Camera: Phoenix ICON (100° FOV). Image size 1240x1240. Wide-field fundus photograph of an infant:
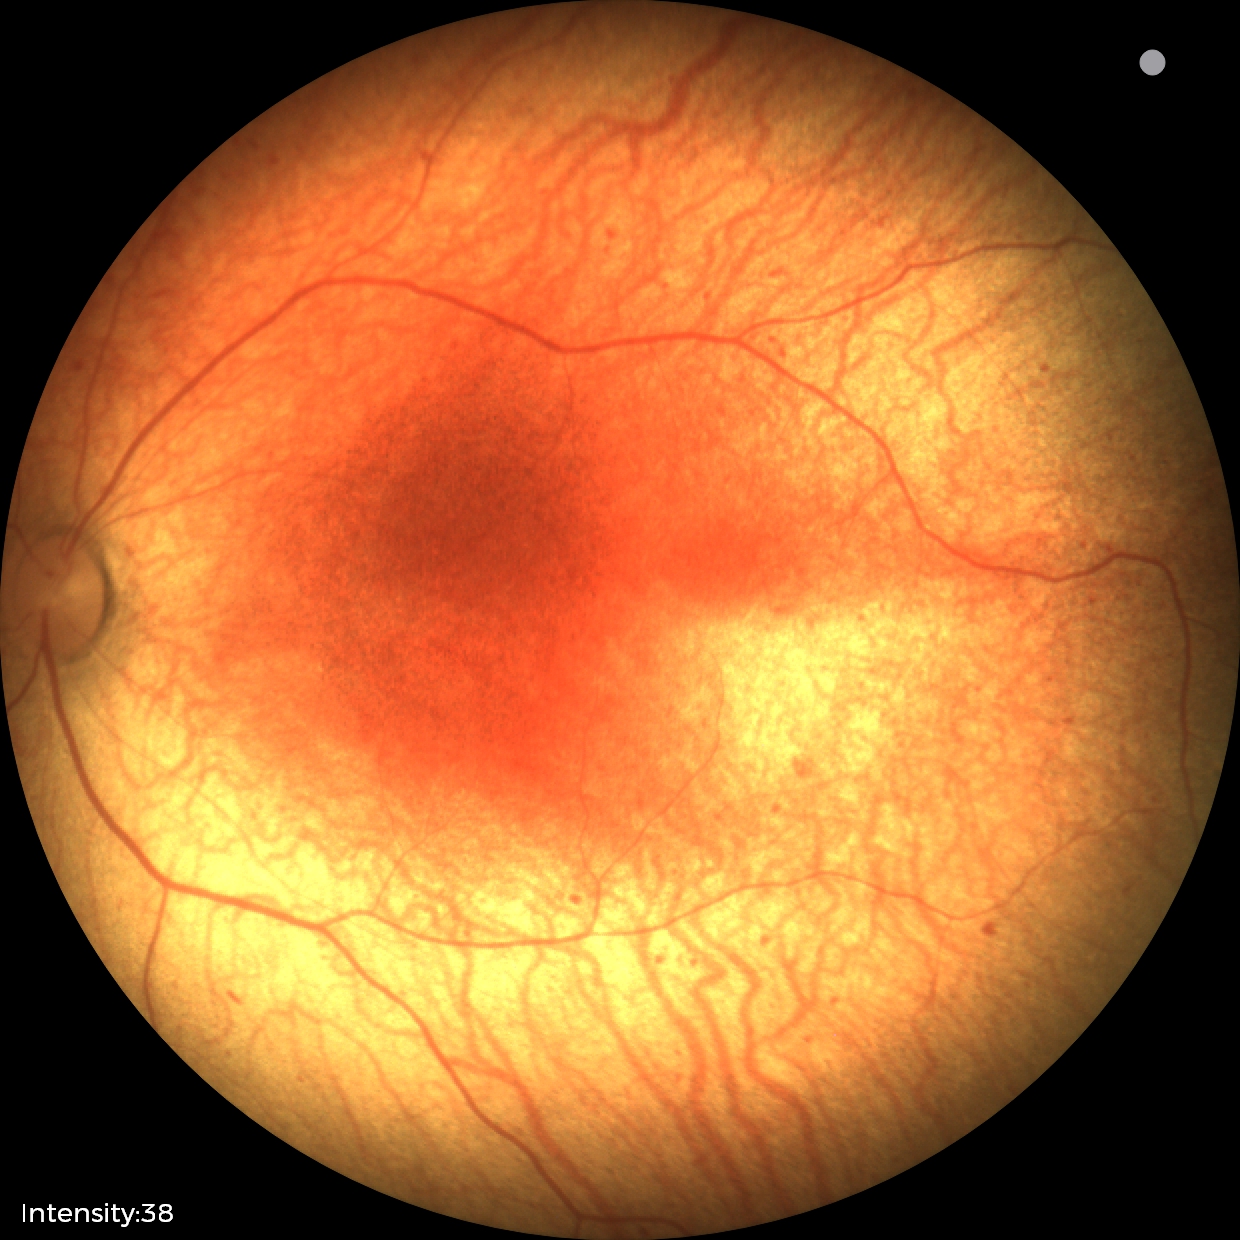 Screening diagnosis: no plus disease; status post retinopathy of prematurity.